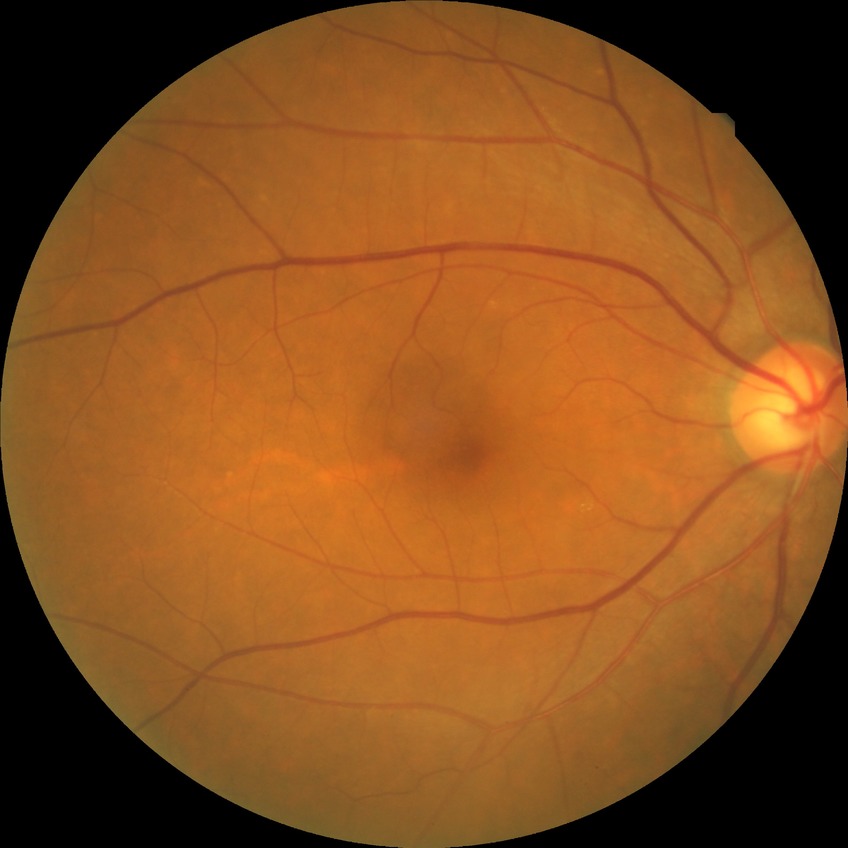 Findings:
• Davis grading: no diabetic retinopathy